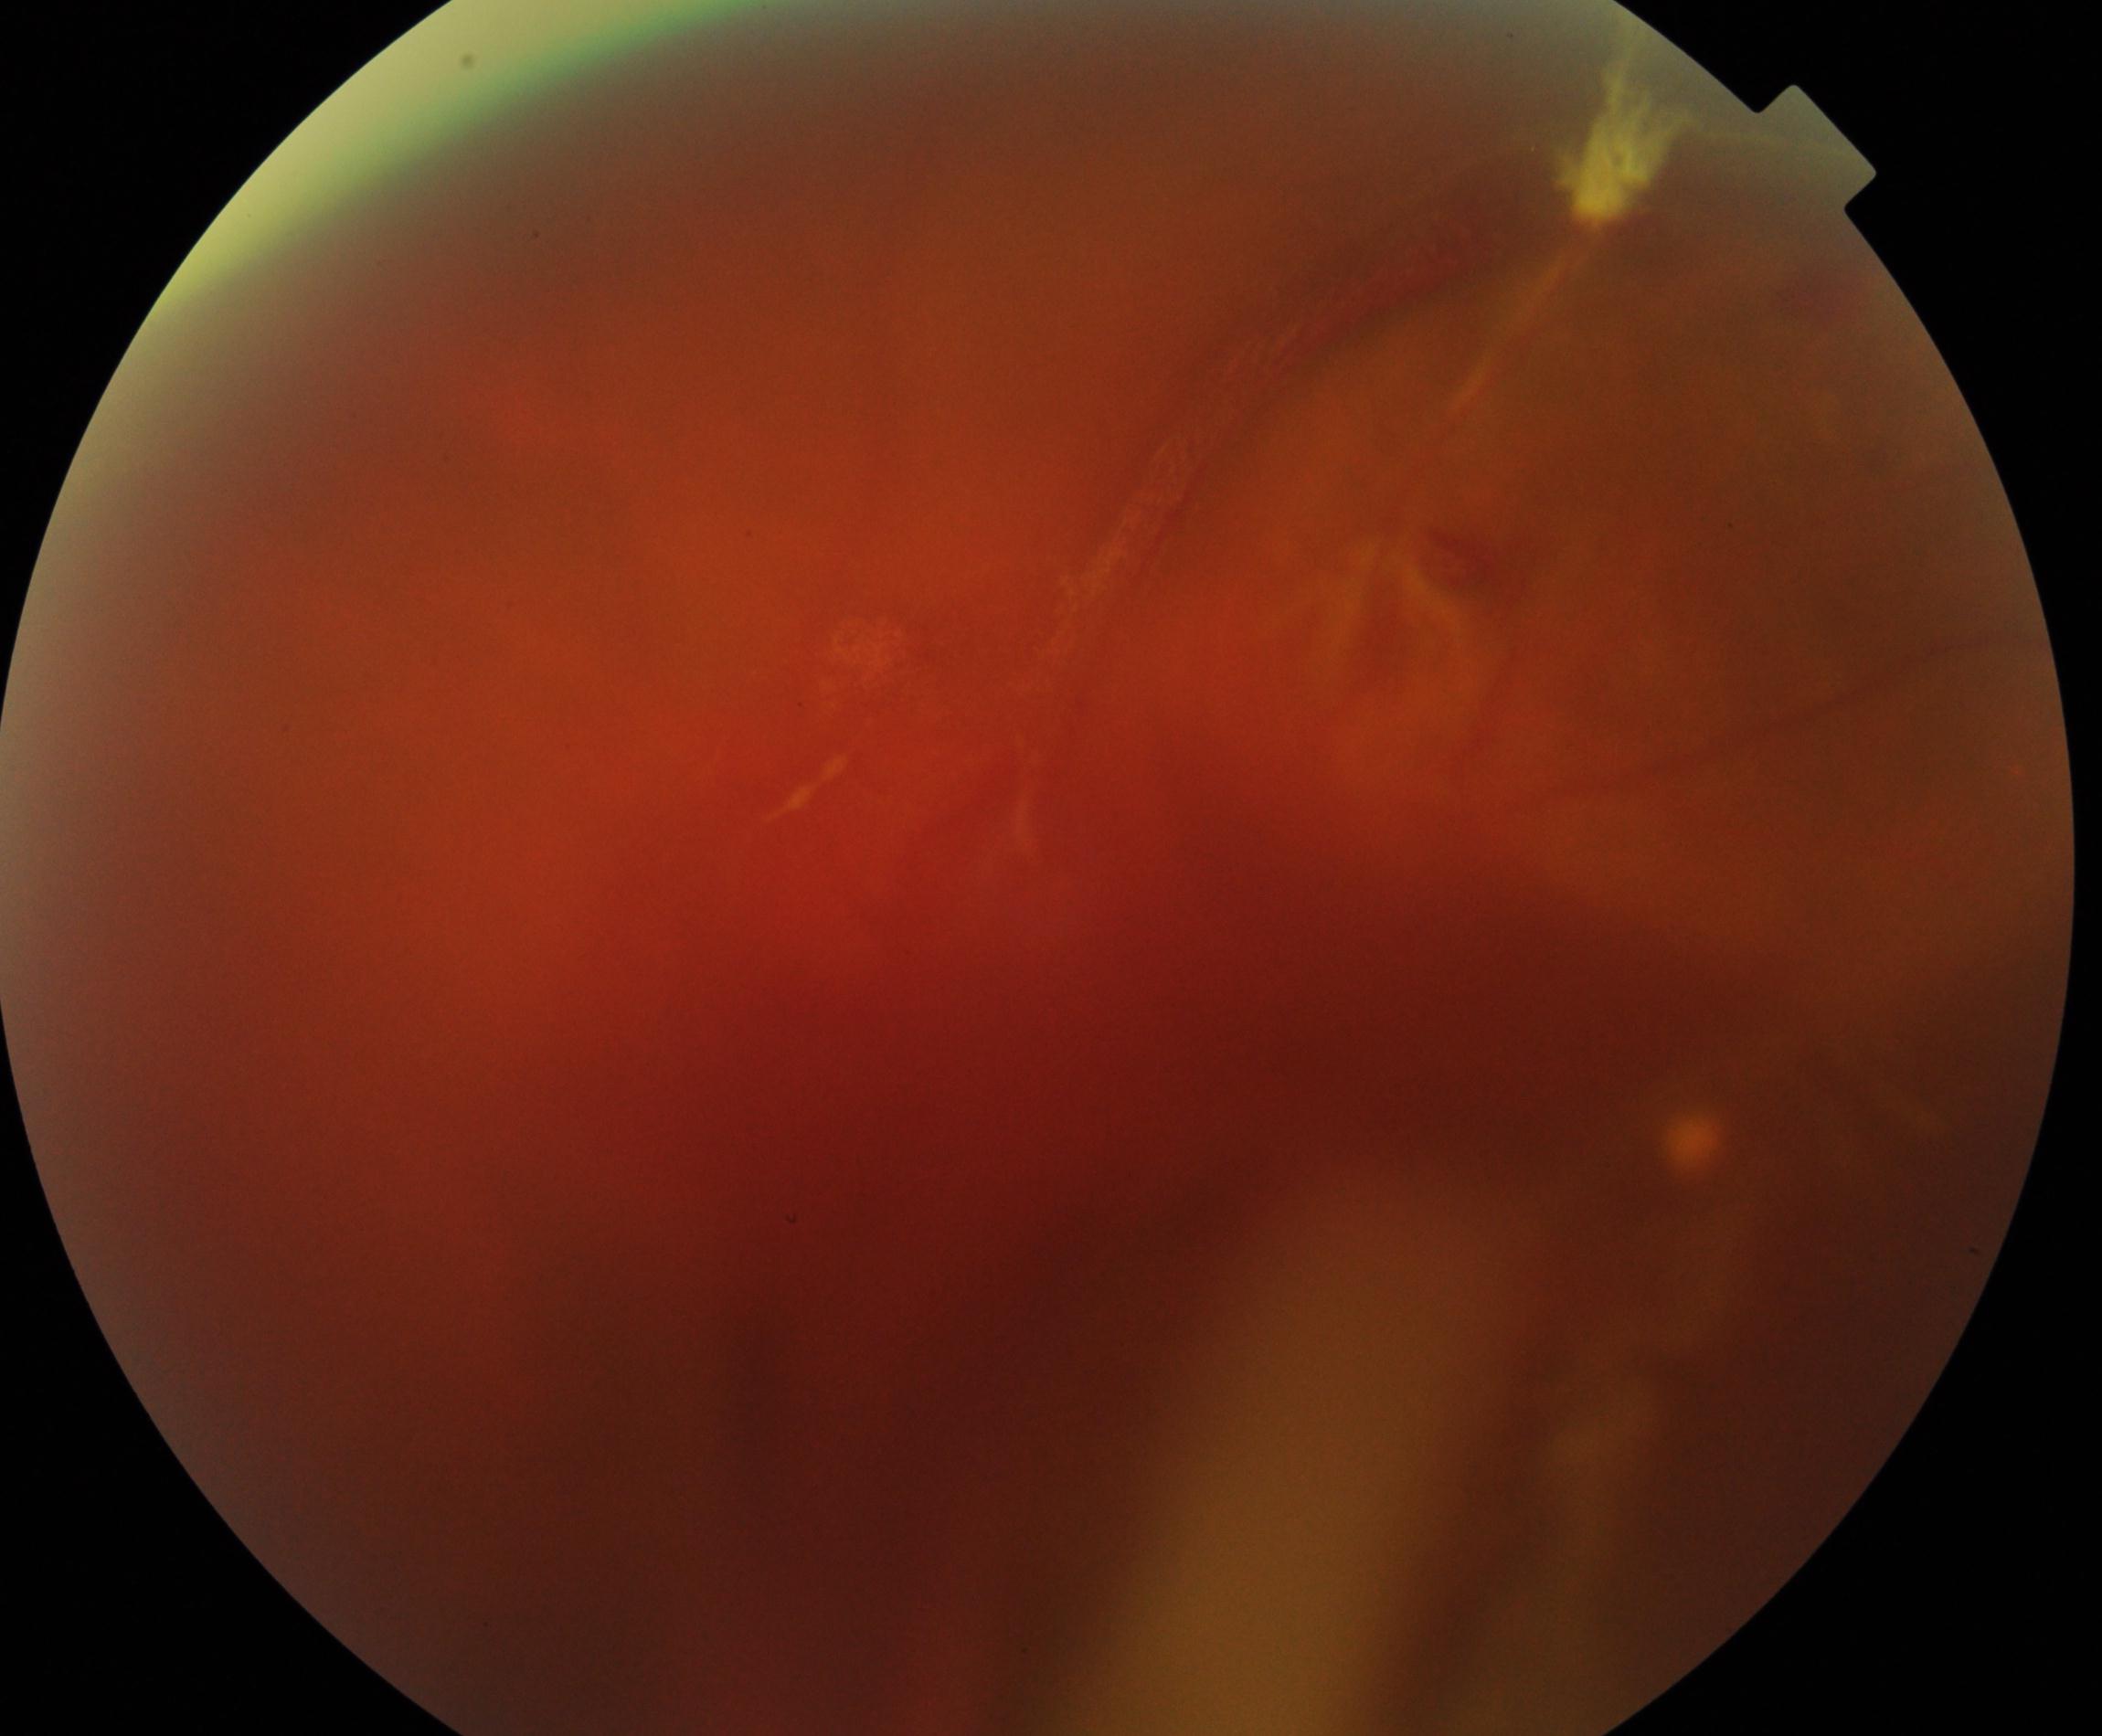
Image quality is poor; more than half the field is obscured. Features suspicious for proliferative diabetic retinopathy.